2184 by 1682 pixels: 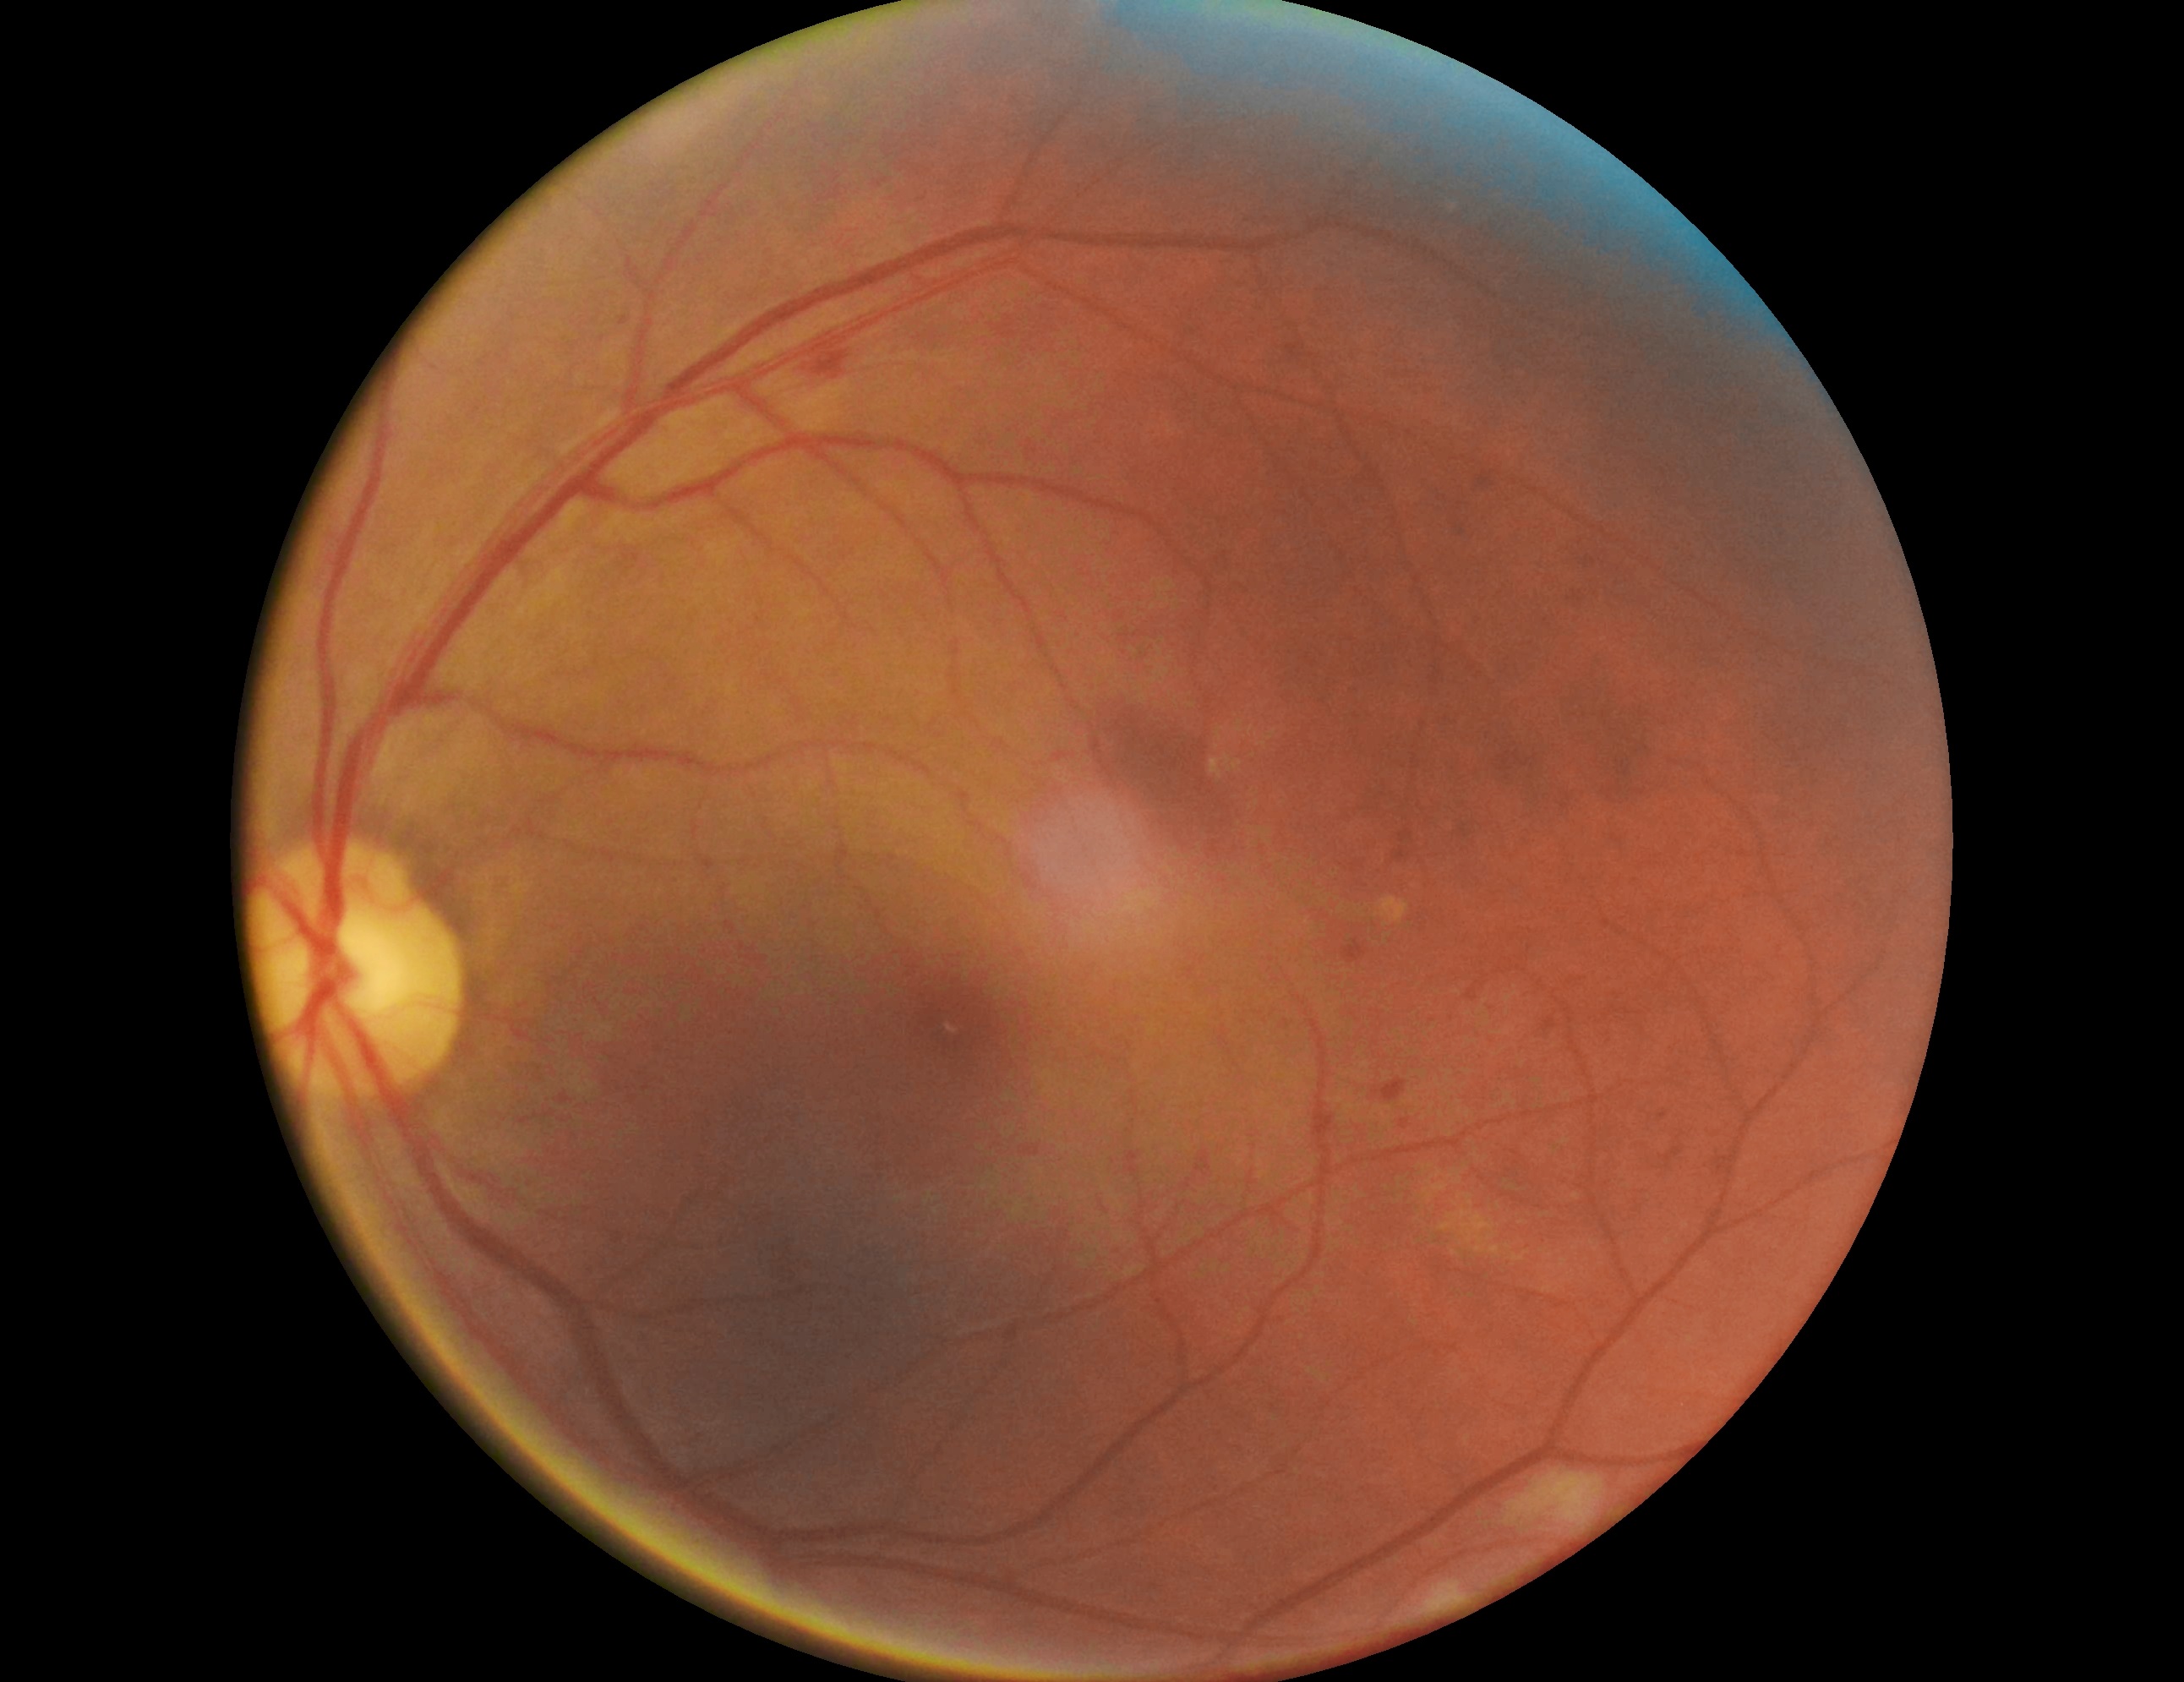 Retinopathy grade: moderate NPDR (2).
The retinopathy is classified as non-proliferative diabetic retinopathy.